2346 by 1568 pixels, 45° FOV:
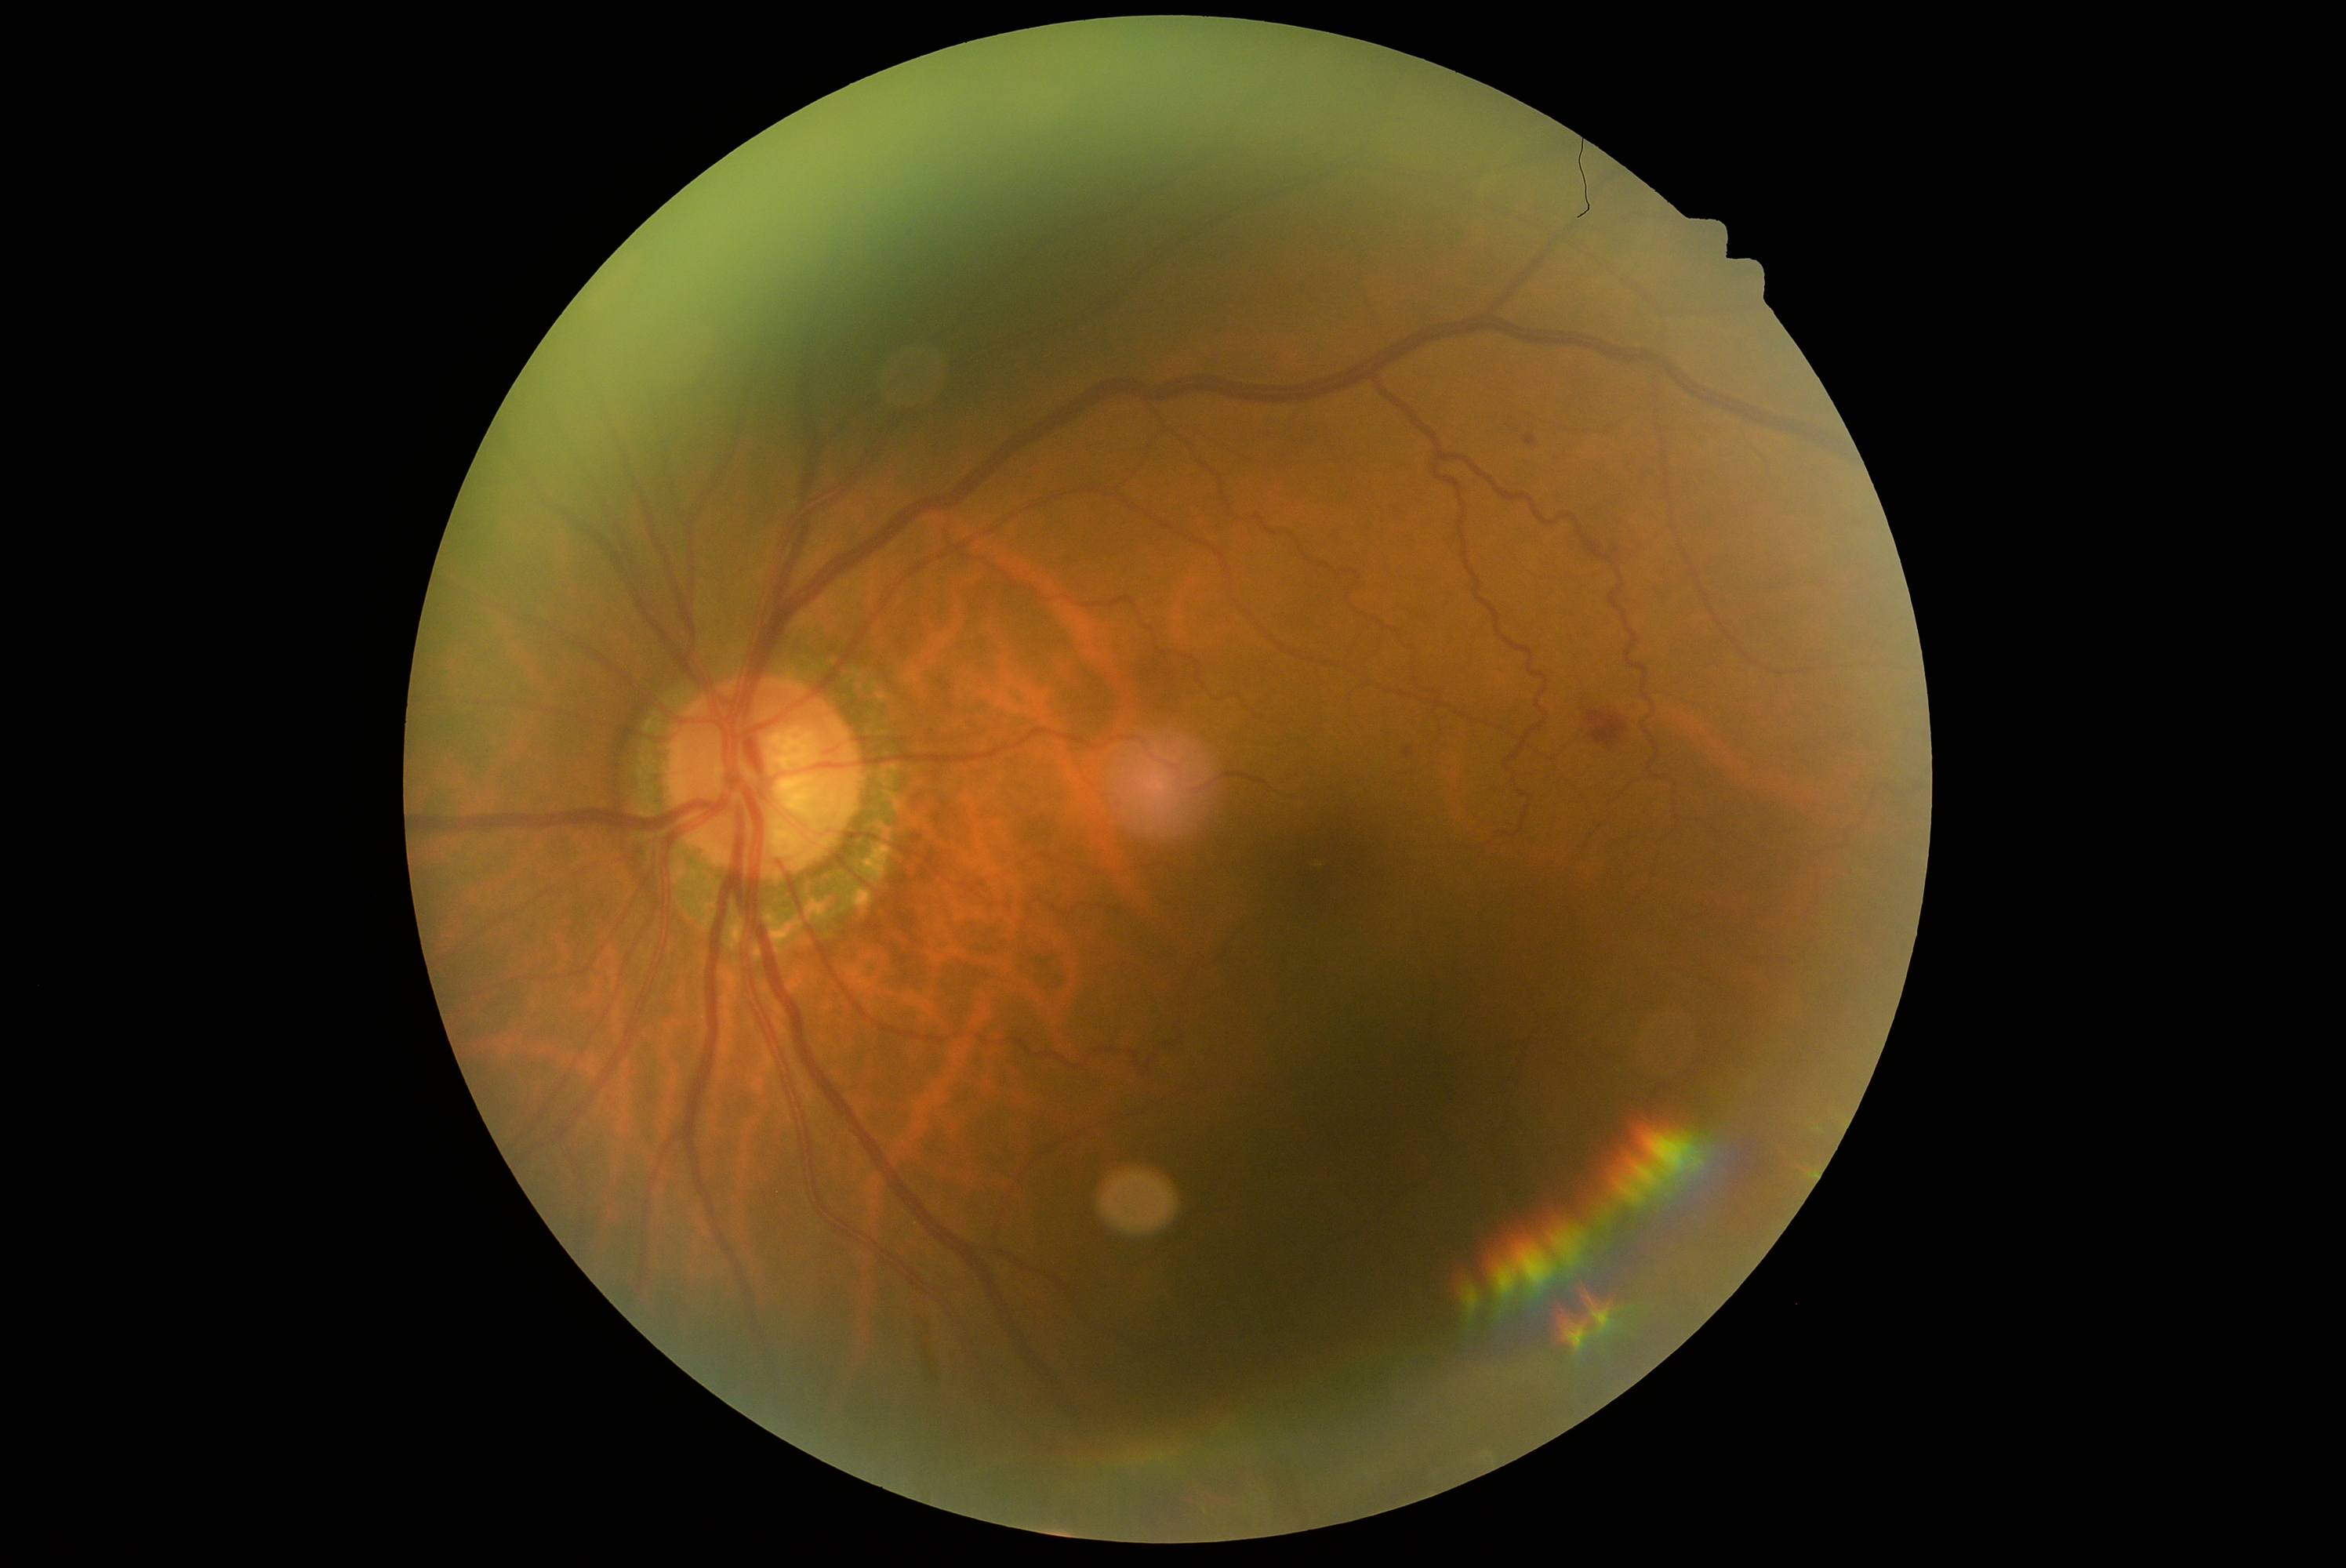

Diabetic retinopathy (DR) is moderate NPDR (grade 2).
The retinopathy is classified as non-proliferative diabetic retinopathy.